2048x1536px, FOV: 45 degrees
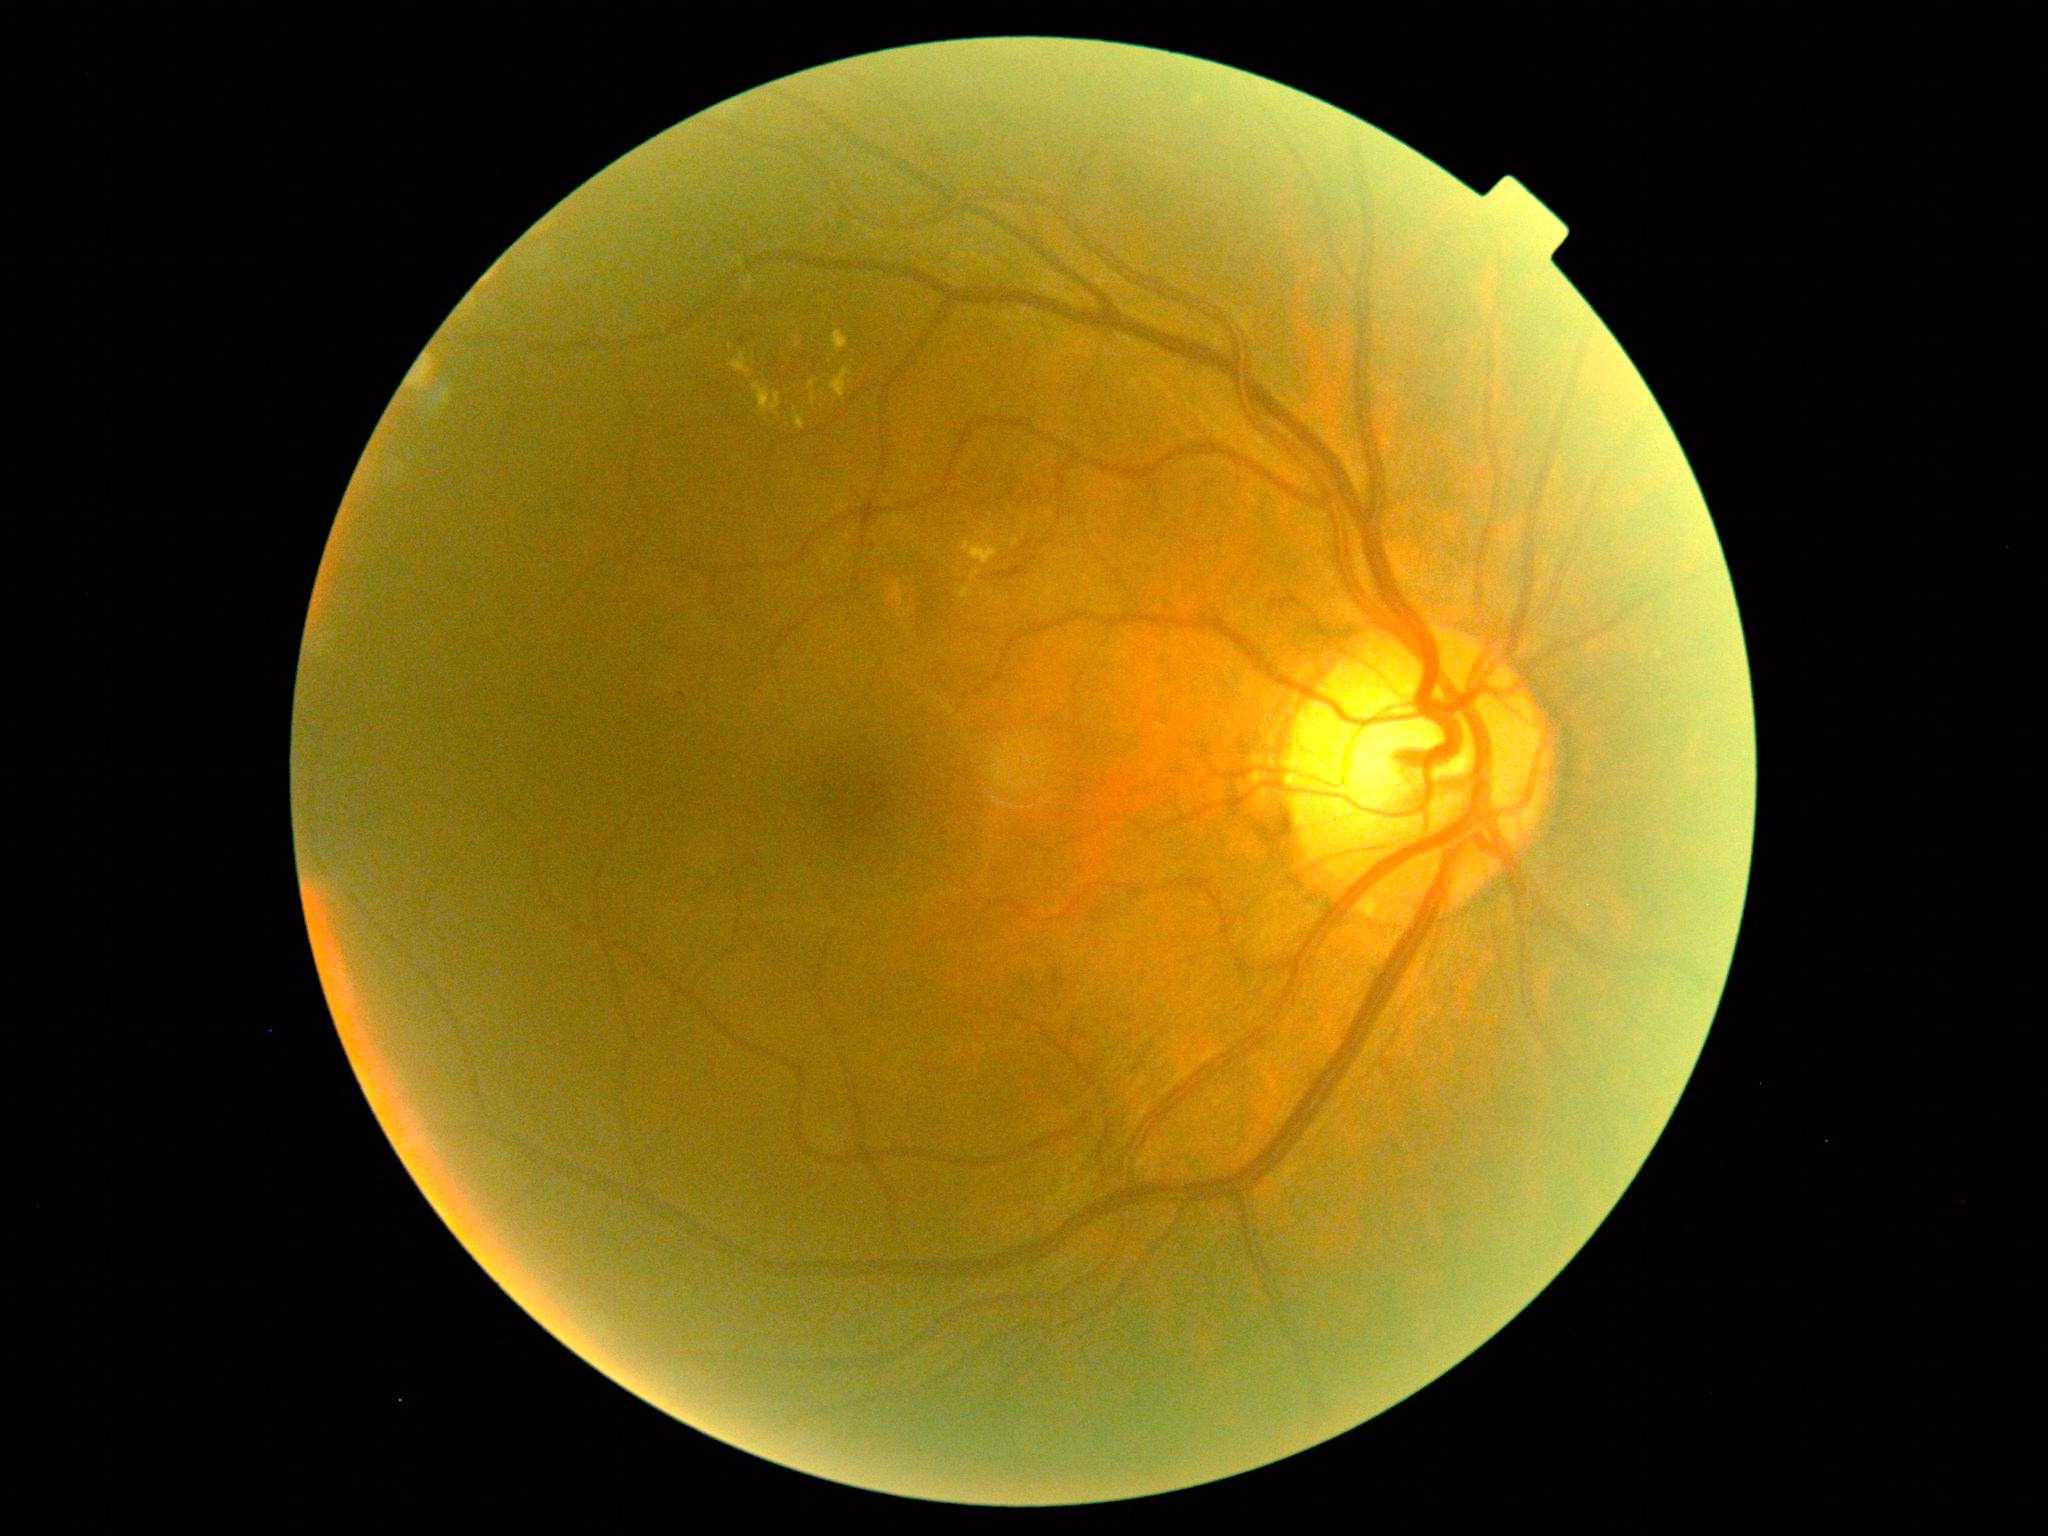
{"dr_grade": "grade 2 (moderate NPDR)"}